Retinal fundus photograph
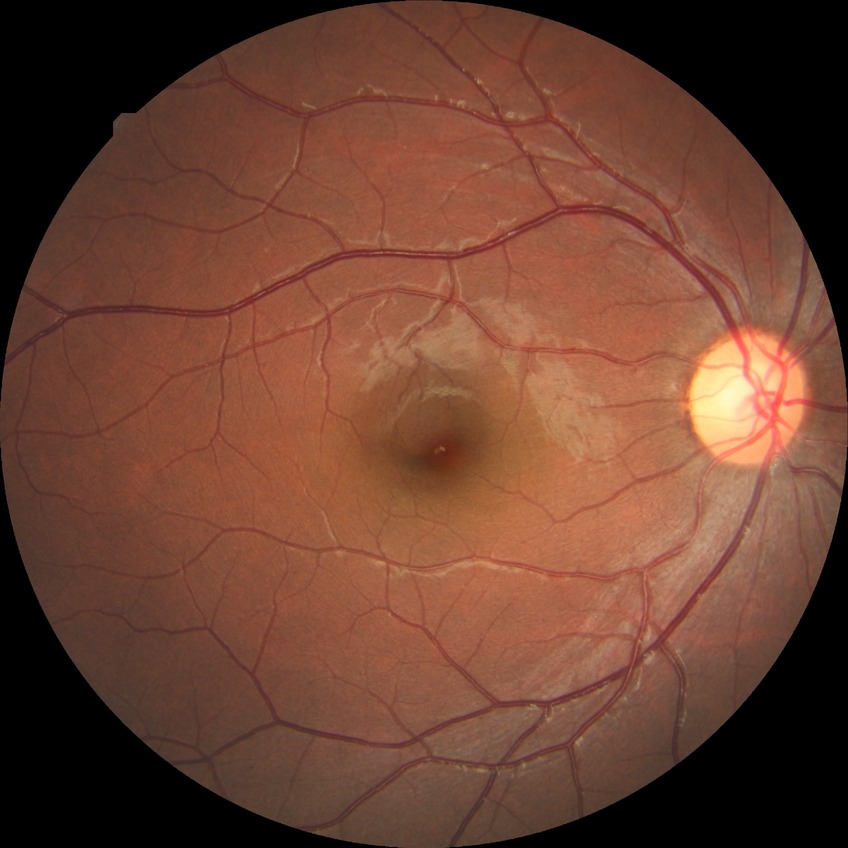

diabetic retinopathy (DR): NDR (no diabetic retinopathy).